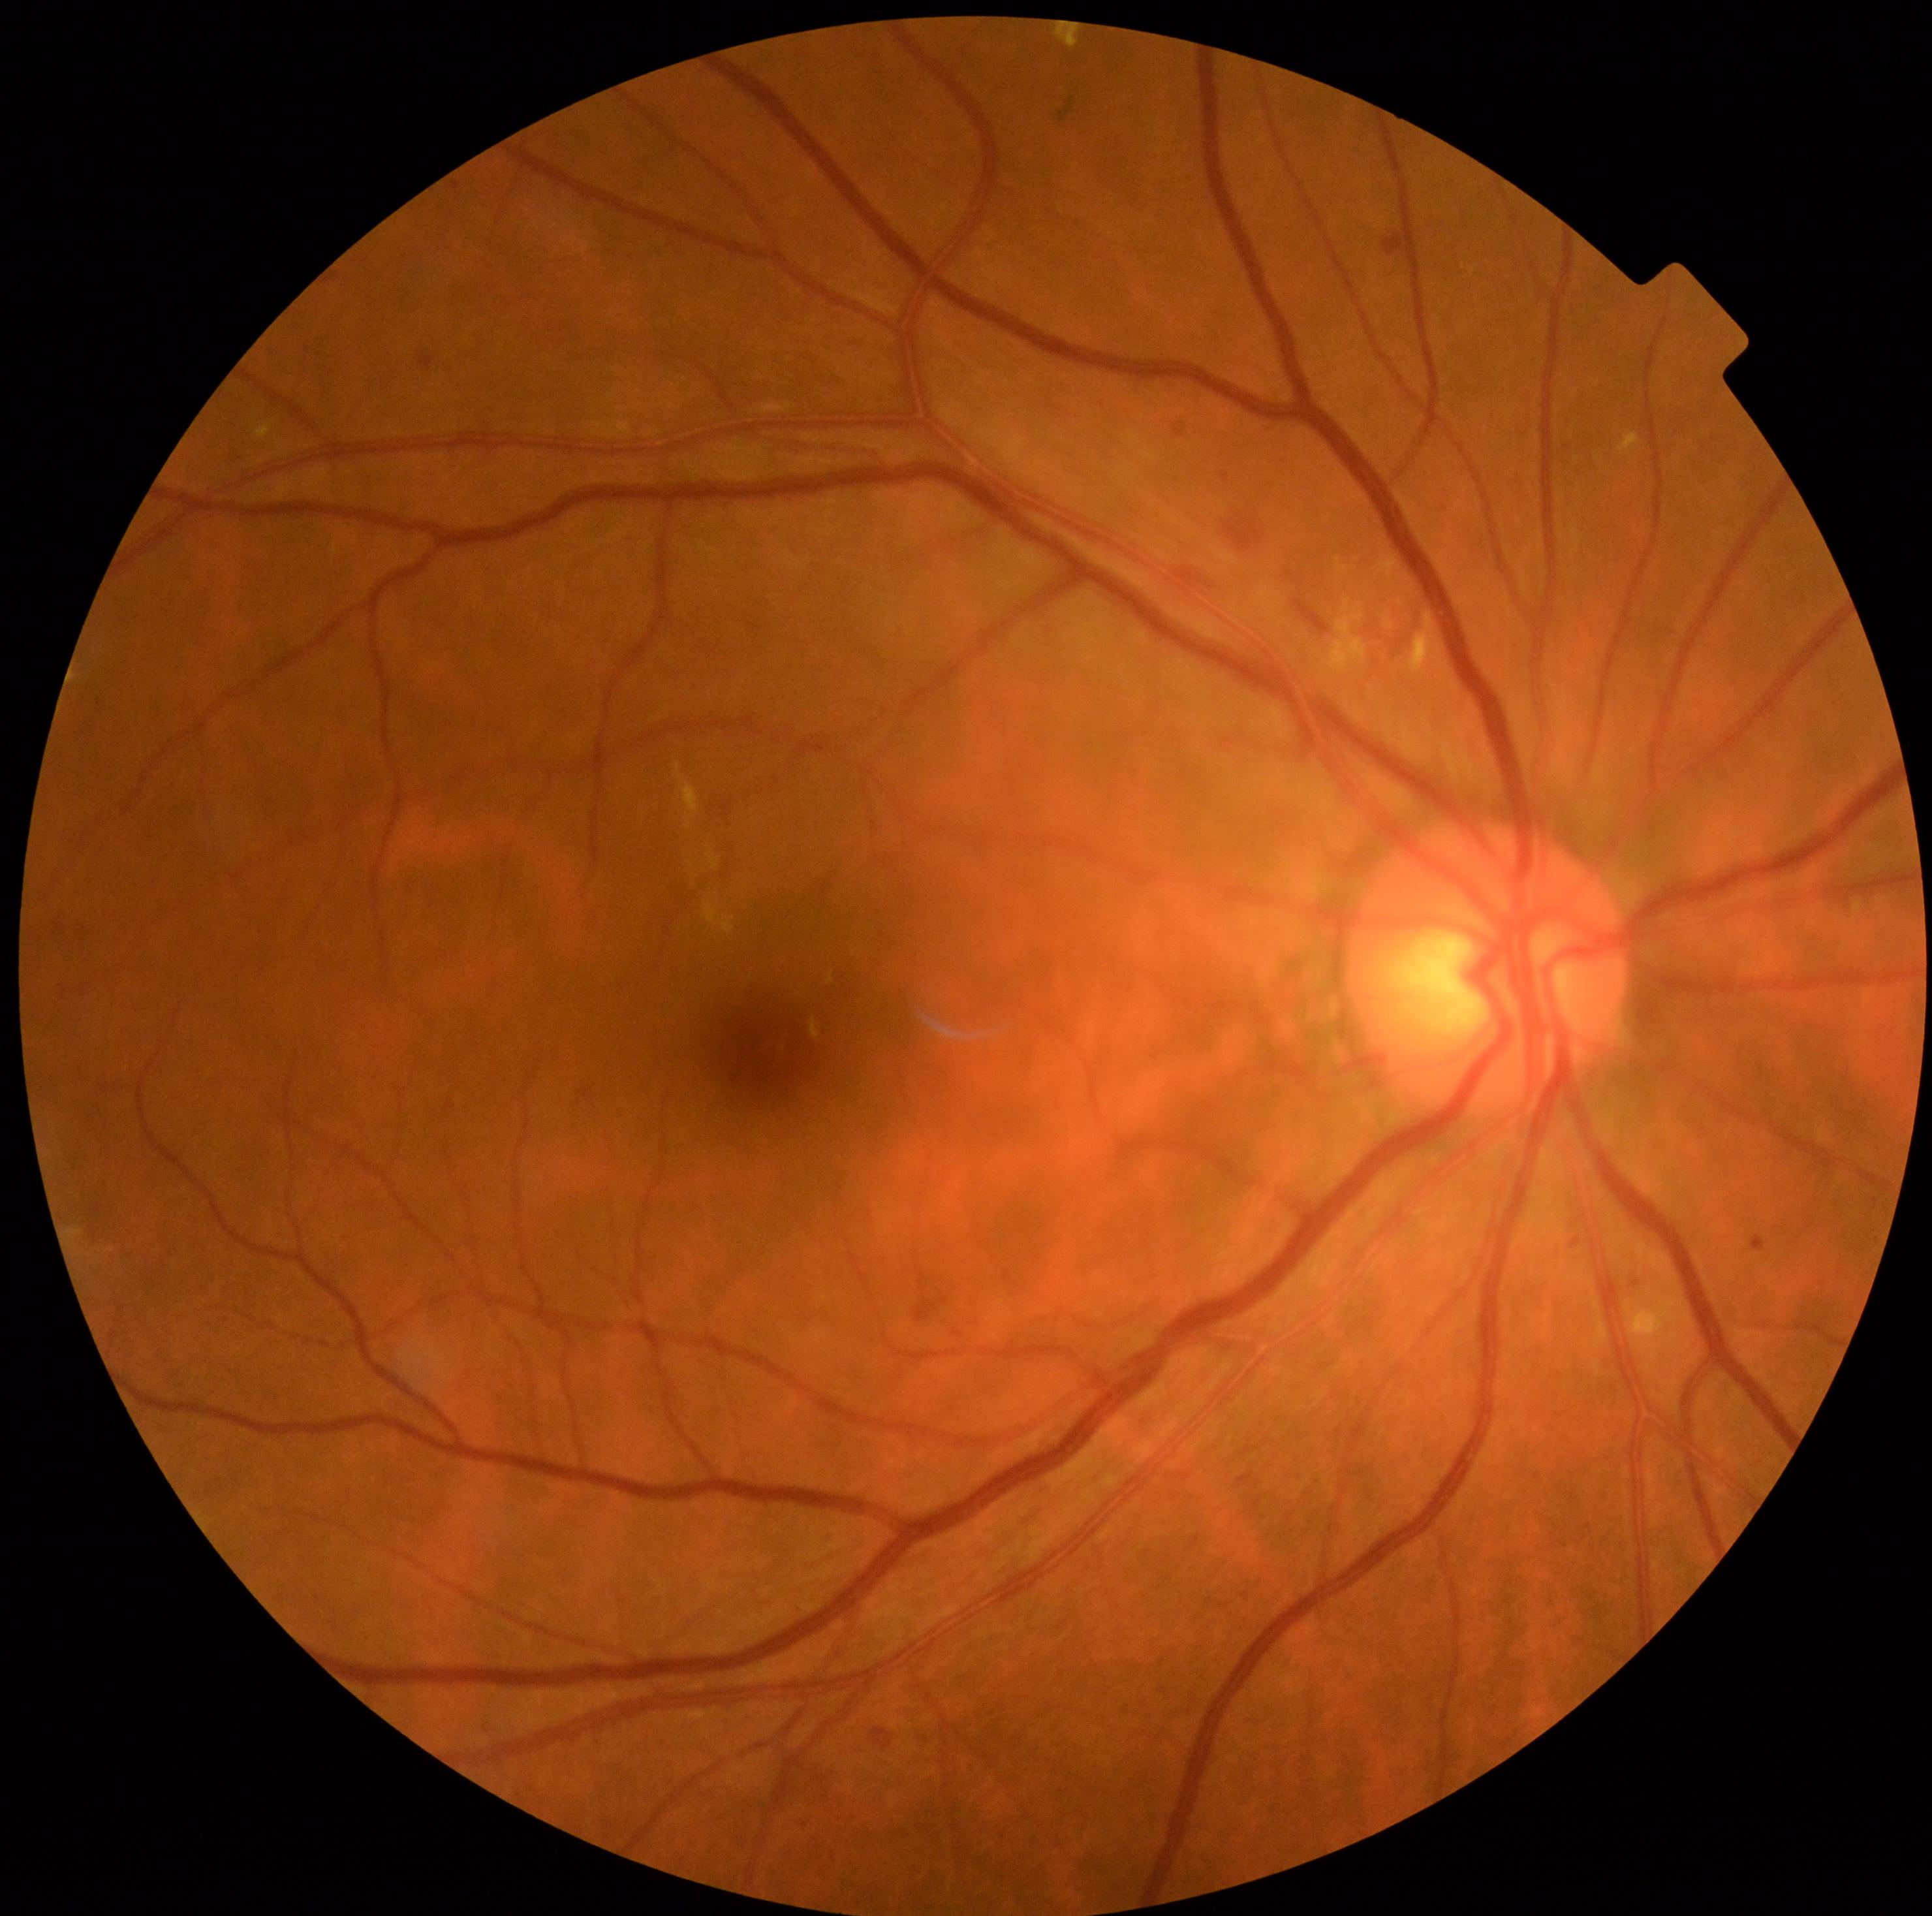
DR grade is 2 (moderate NPDR).